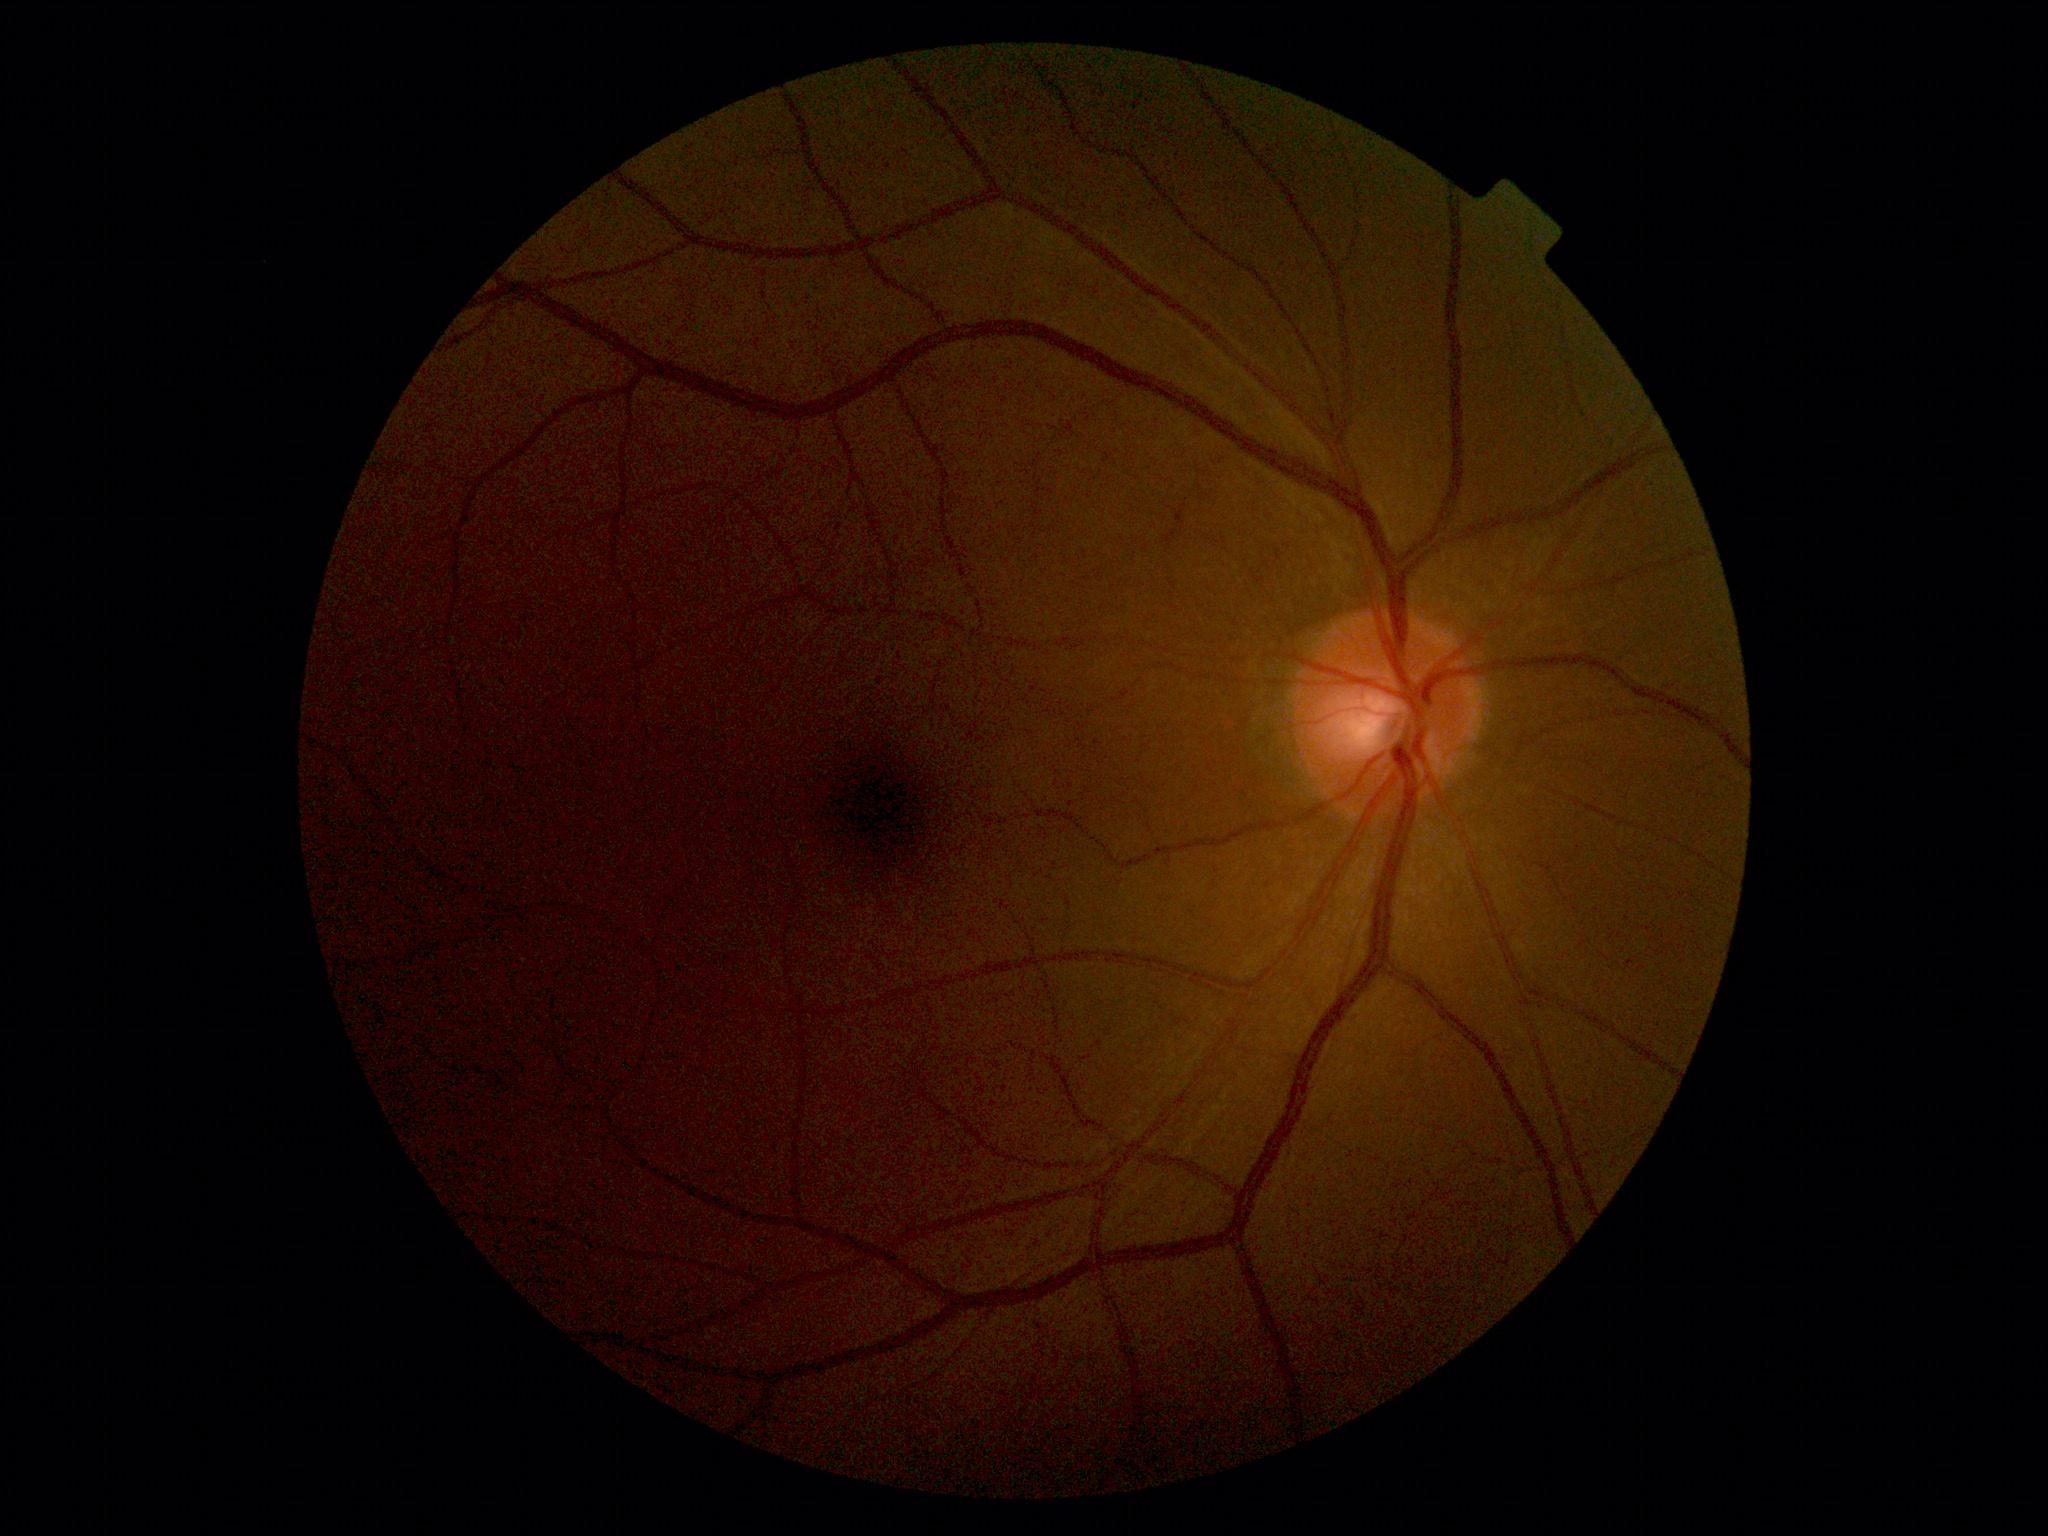
Diabetic retinopathy is grade 0.